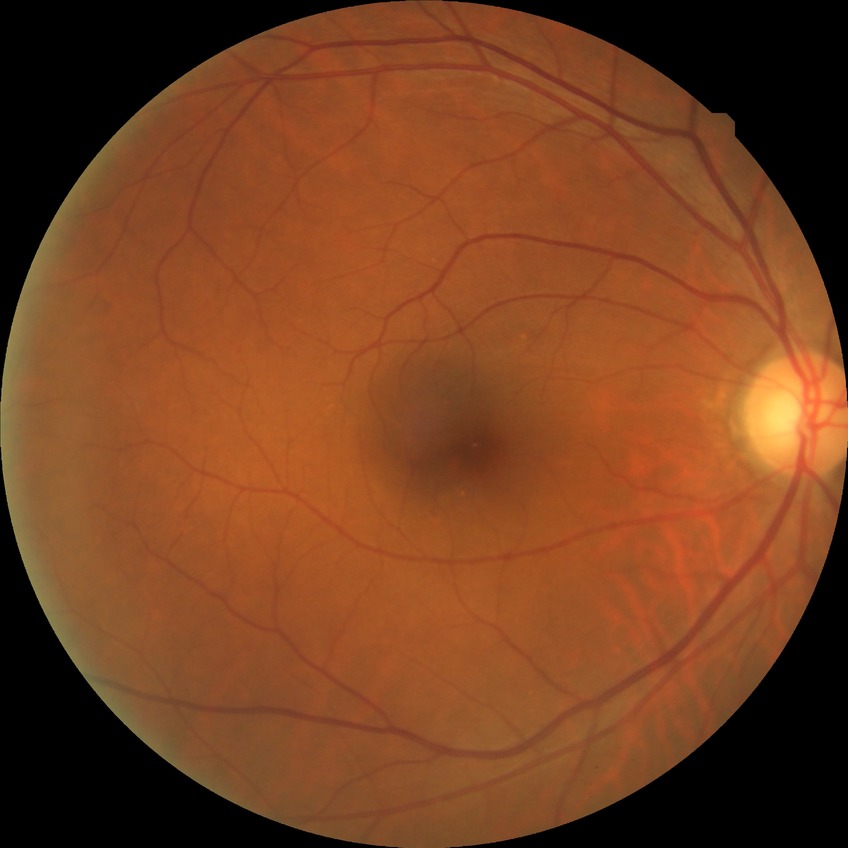 diabetic retinopathy (DR): NDR (no diabetic retinopathy).